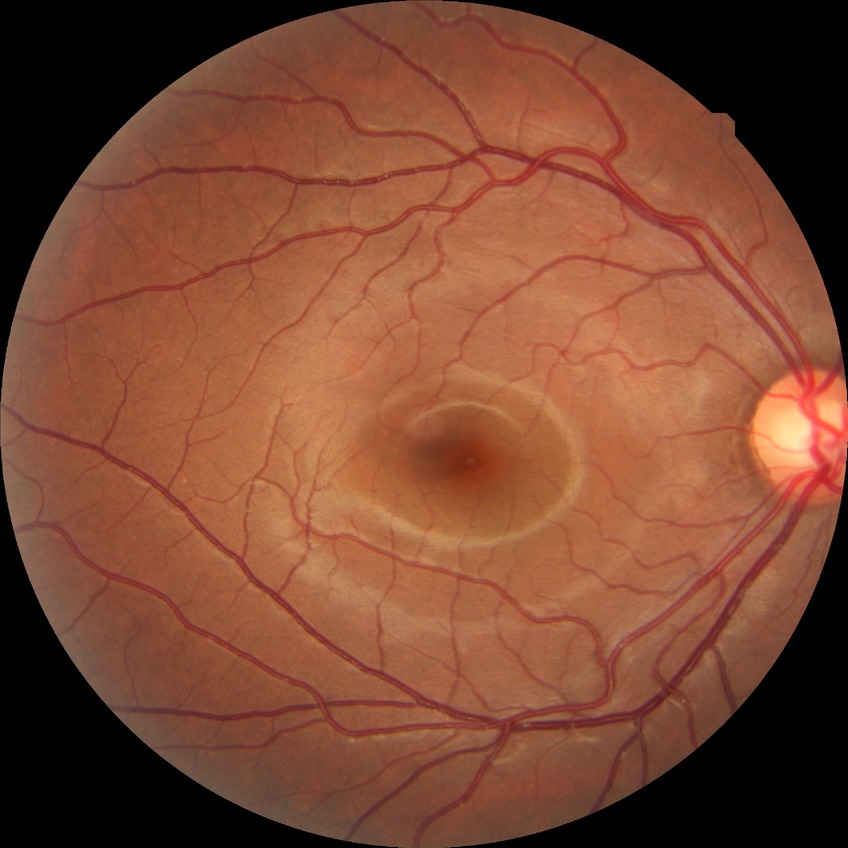
diabetic retinopathy (DR): NDR (no diabetic retinopathy).